Nonmydriatic · diabetic retinopathy graded by the modified Davis classification:
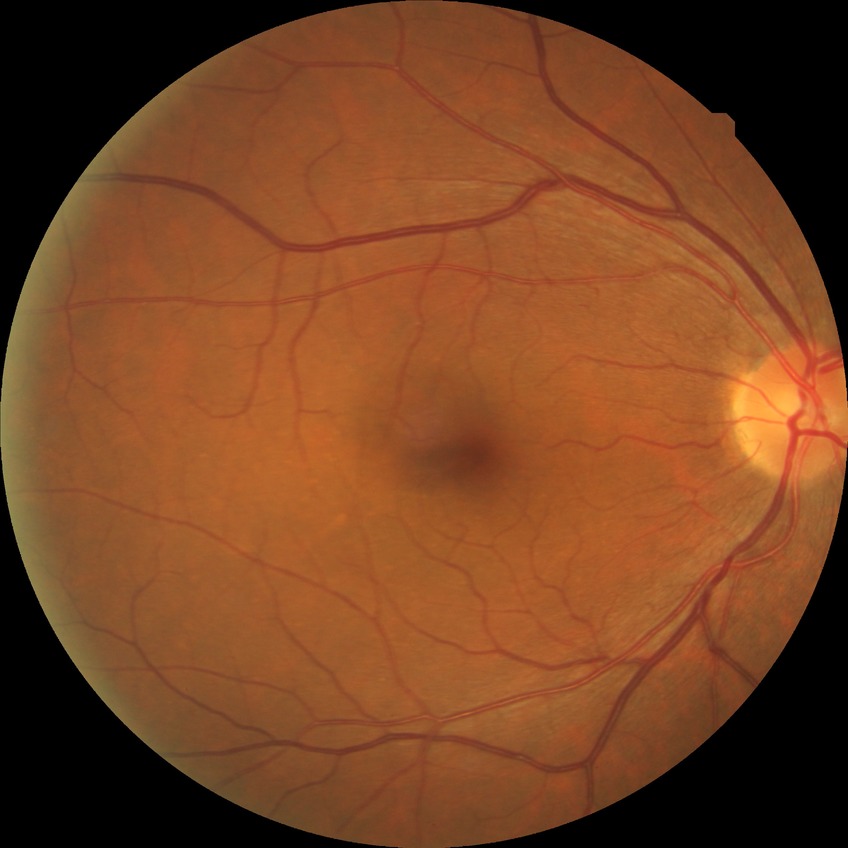 {"davis_grade": "no diabetic retinopathy (NDR)"}